Wide-field fundus photograph of an infant
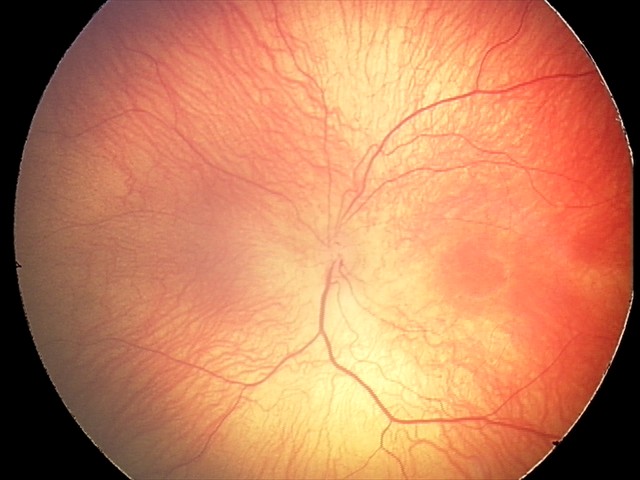

Series diagnosed as ROP stage 1.